DR severity per modified Davis staging:
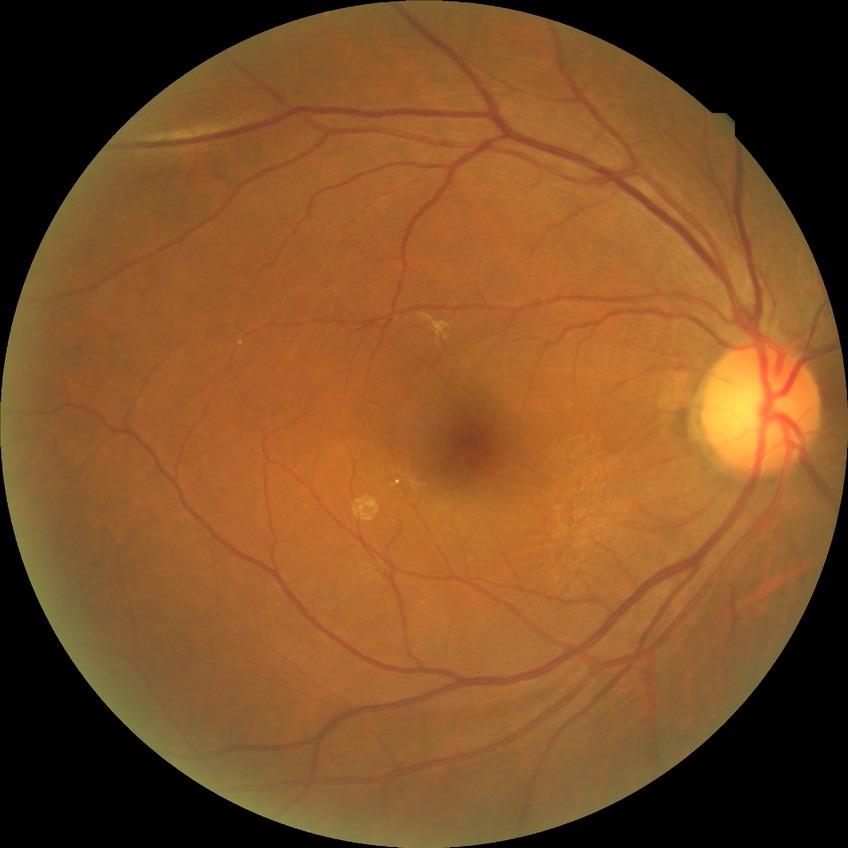 Retinopathy stage is no diabetic retinopathy.